Dilated-pupil acquisition; color fundus photograph
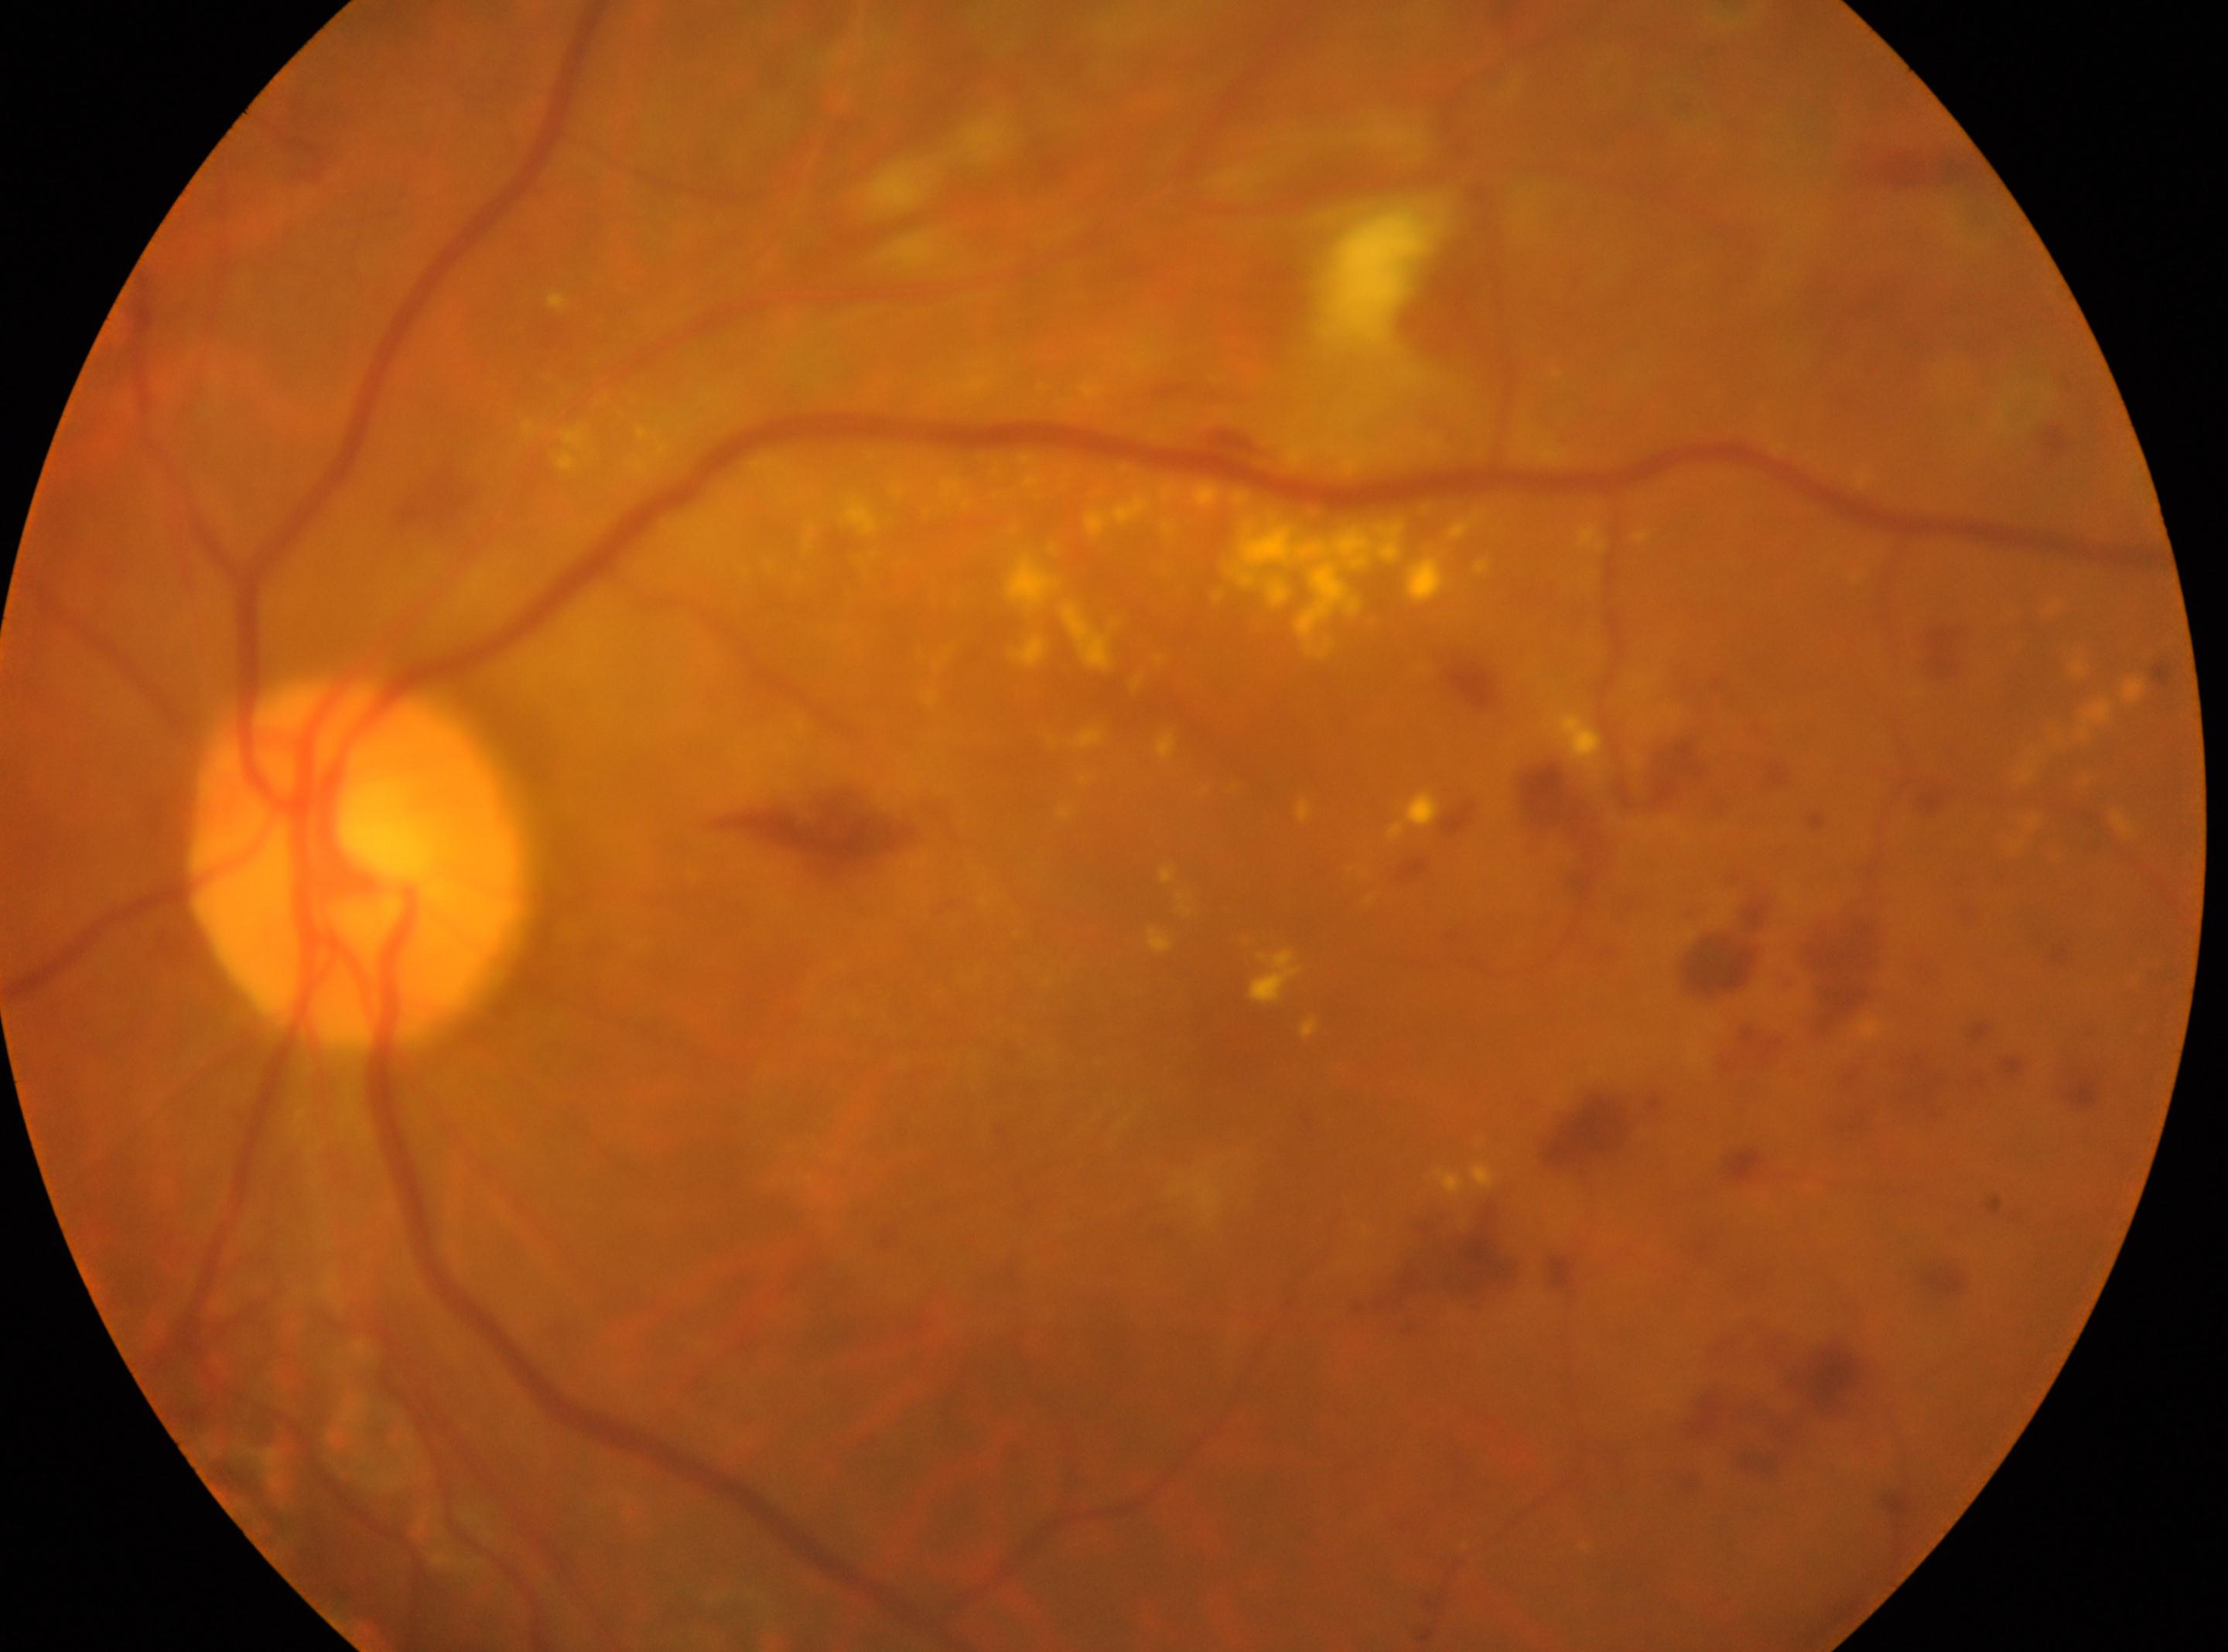
Retinopathy: grade 2 (moderate NPDR). Optic disc center: (359,862). Fovea: (1233,1032). Disease class: non-proliferative diabetic retinopathy. This is the left eye.